Camera: Clarity RetCam 3 (130° FOV). Image size 640x480. Pediatric retinal photograph (wide-field) — 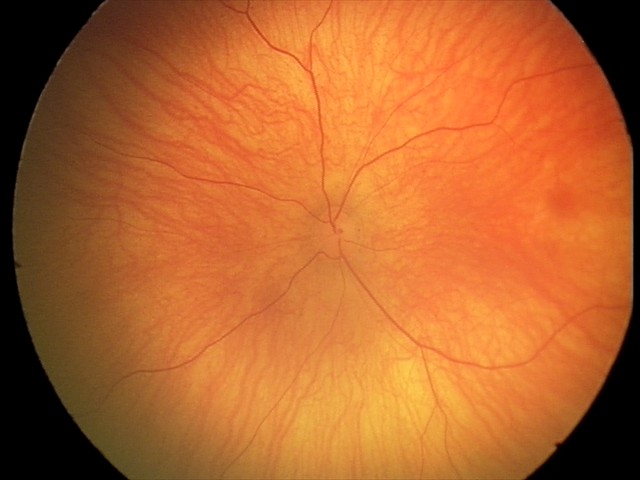
Screening examination diagnosed as physiological.